52-year-old patient; pachymetry 541 µm; axial length (AL) 23.85 mm; intraocular pressure 18 mmHg by non-contact tonometry — 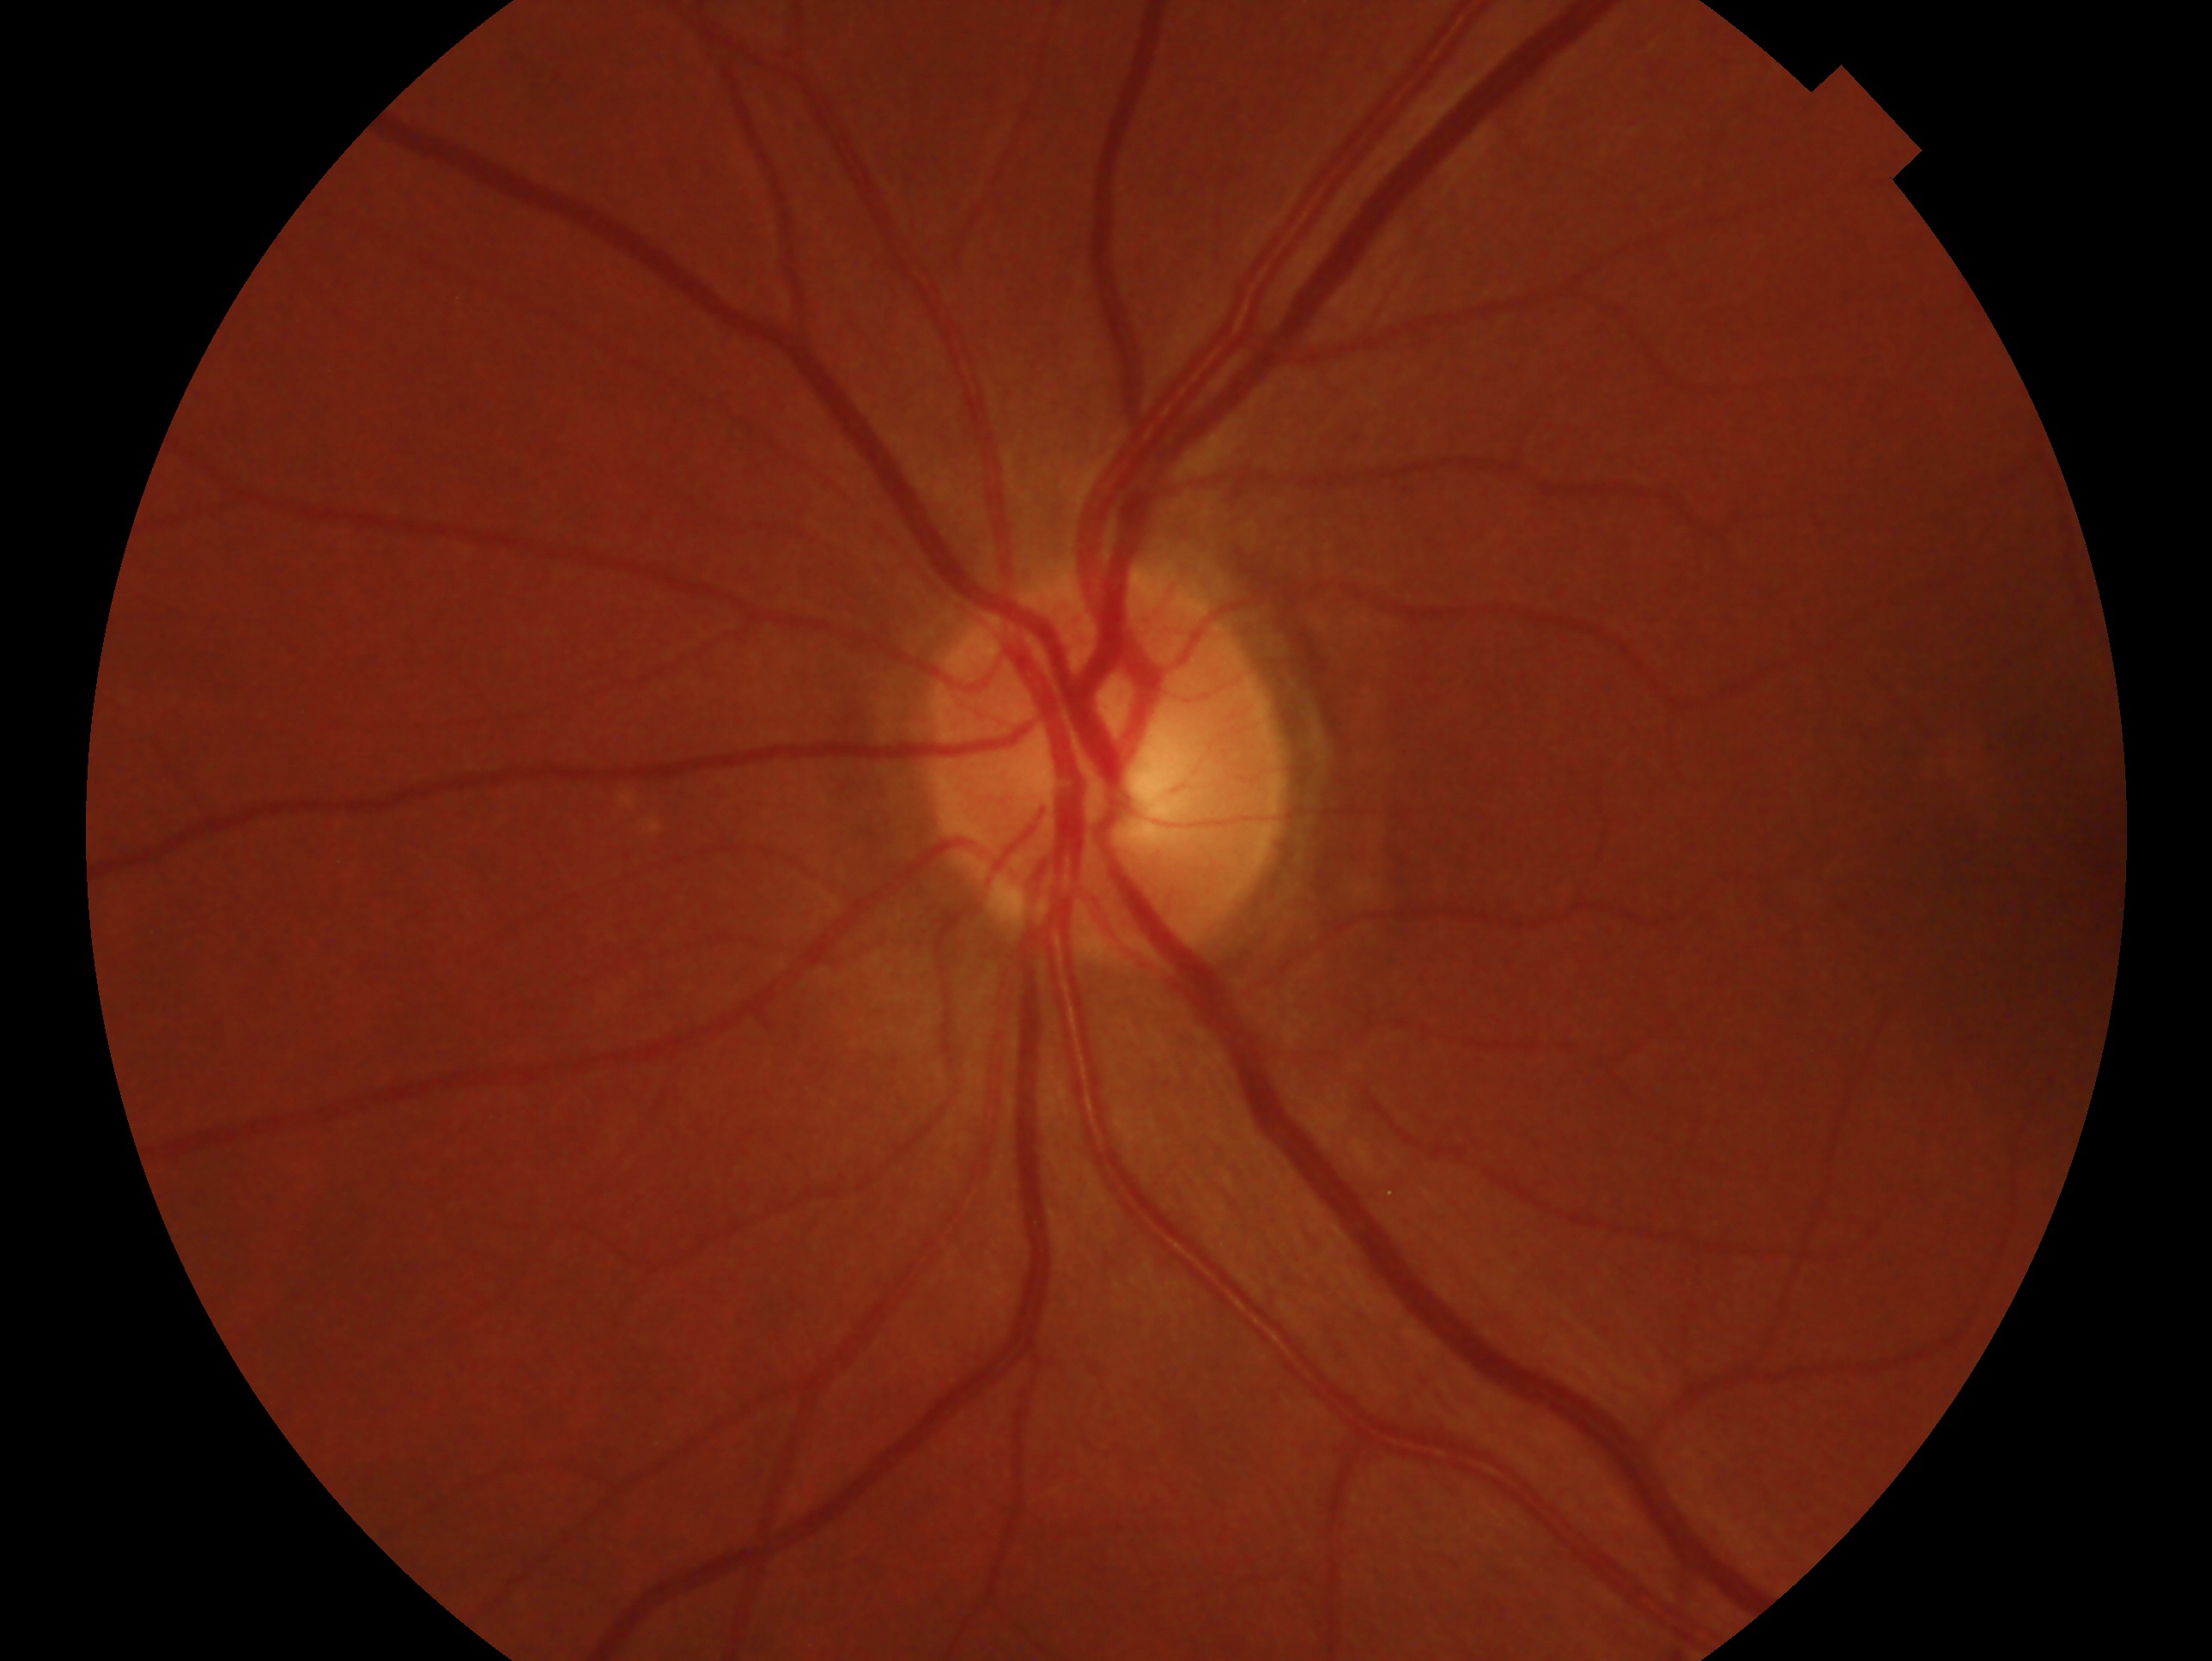
glaucoma status: no glaucoma
laterality: oculus sinister